Graded on the modified Davis scale: 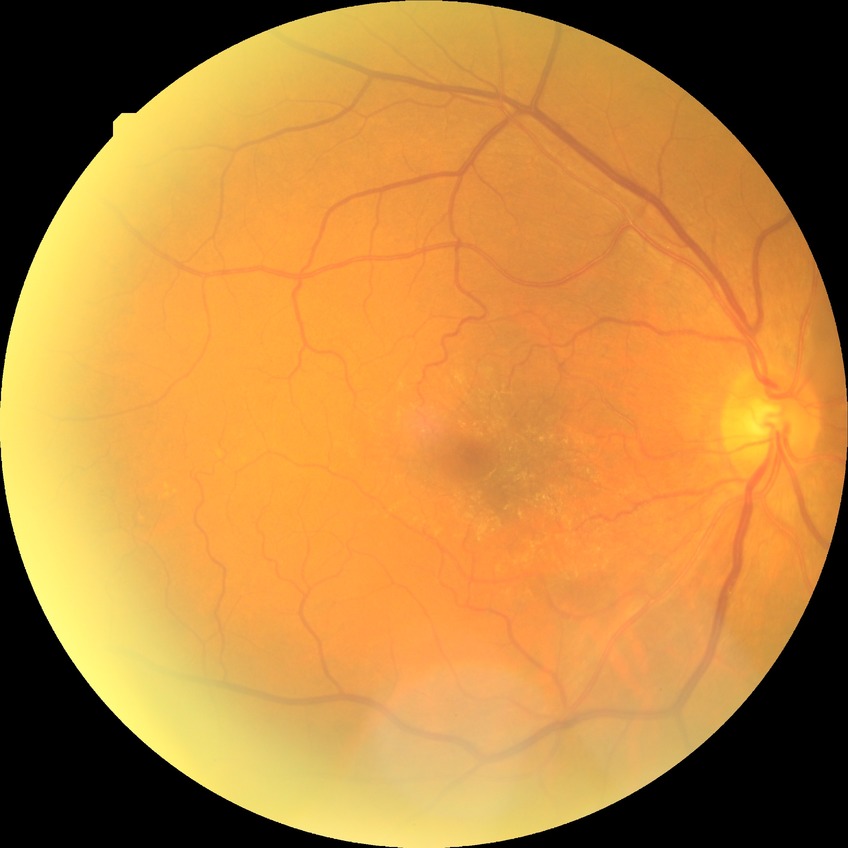 Diabetic retinopathy (DR) is NDR (no diabetic retinopathy).